Wide-field fundus image from infant ROP screening: 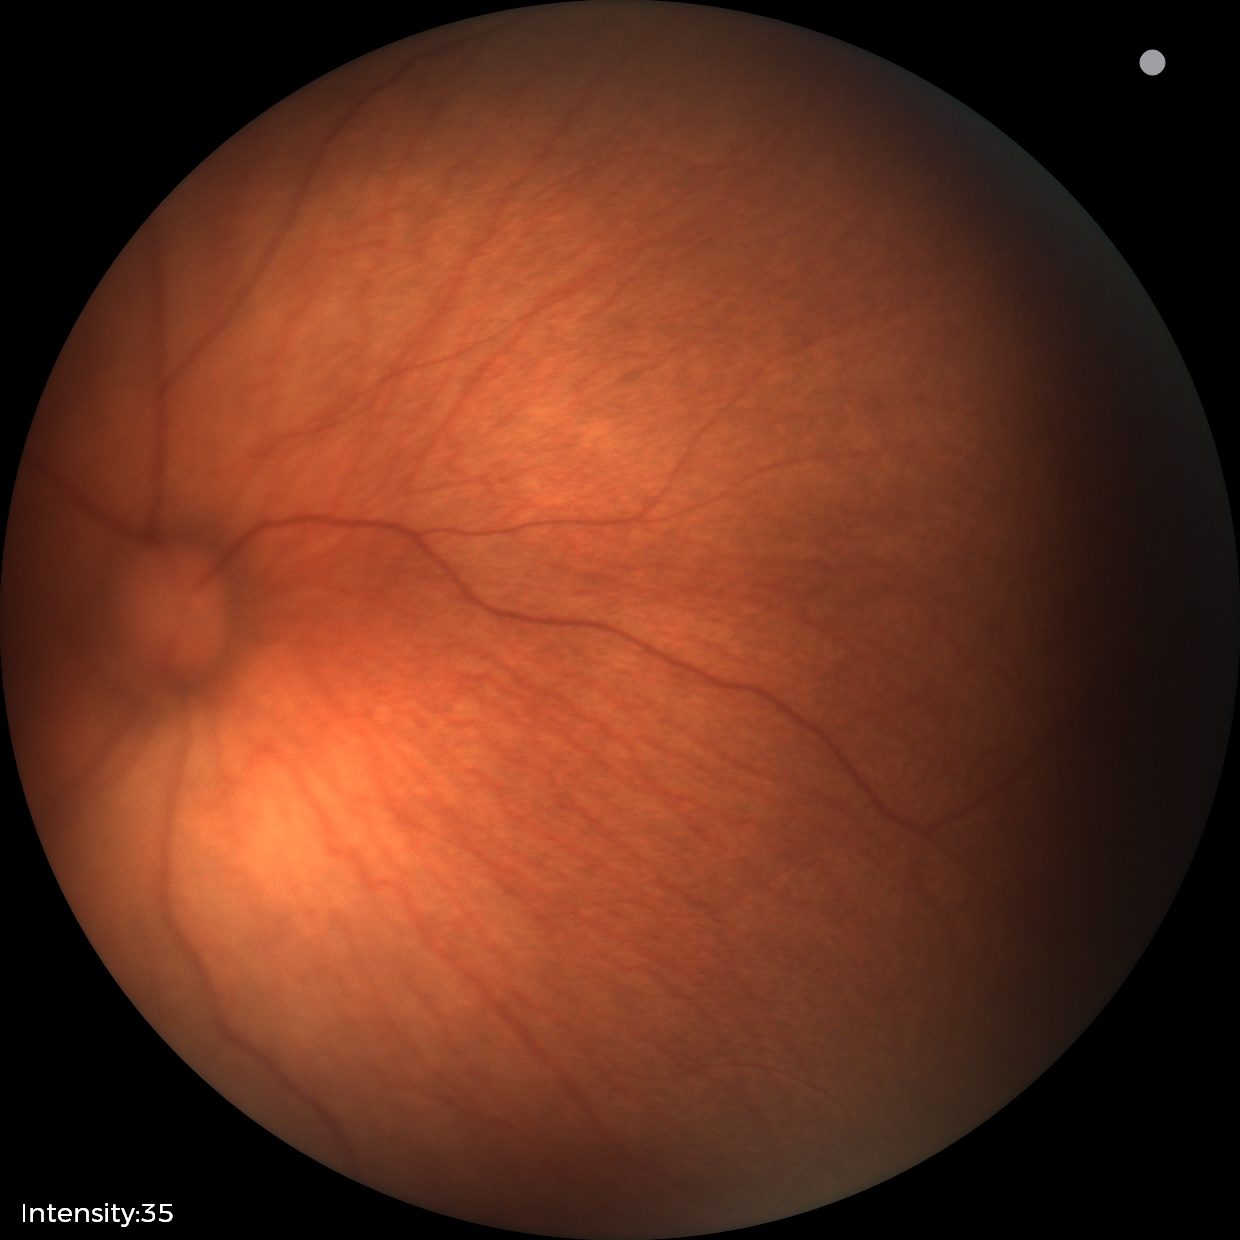
Screening diagnosis = no abnormalities.